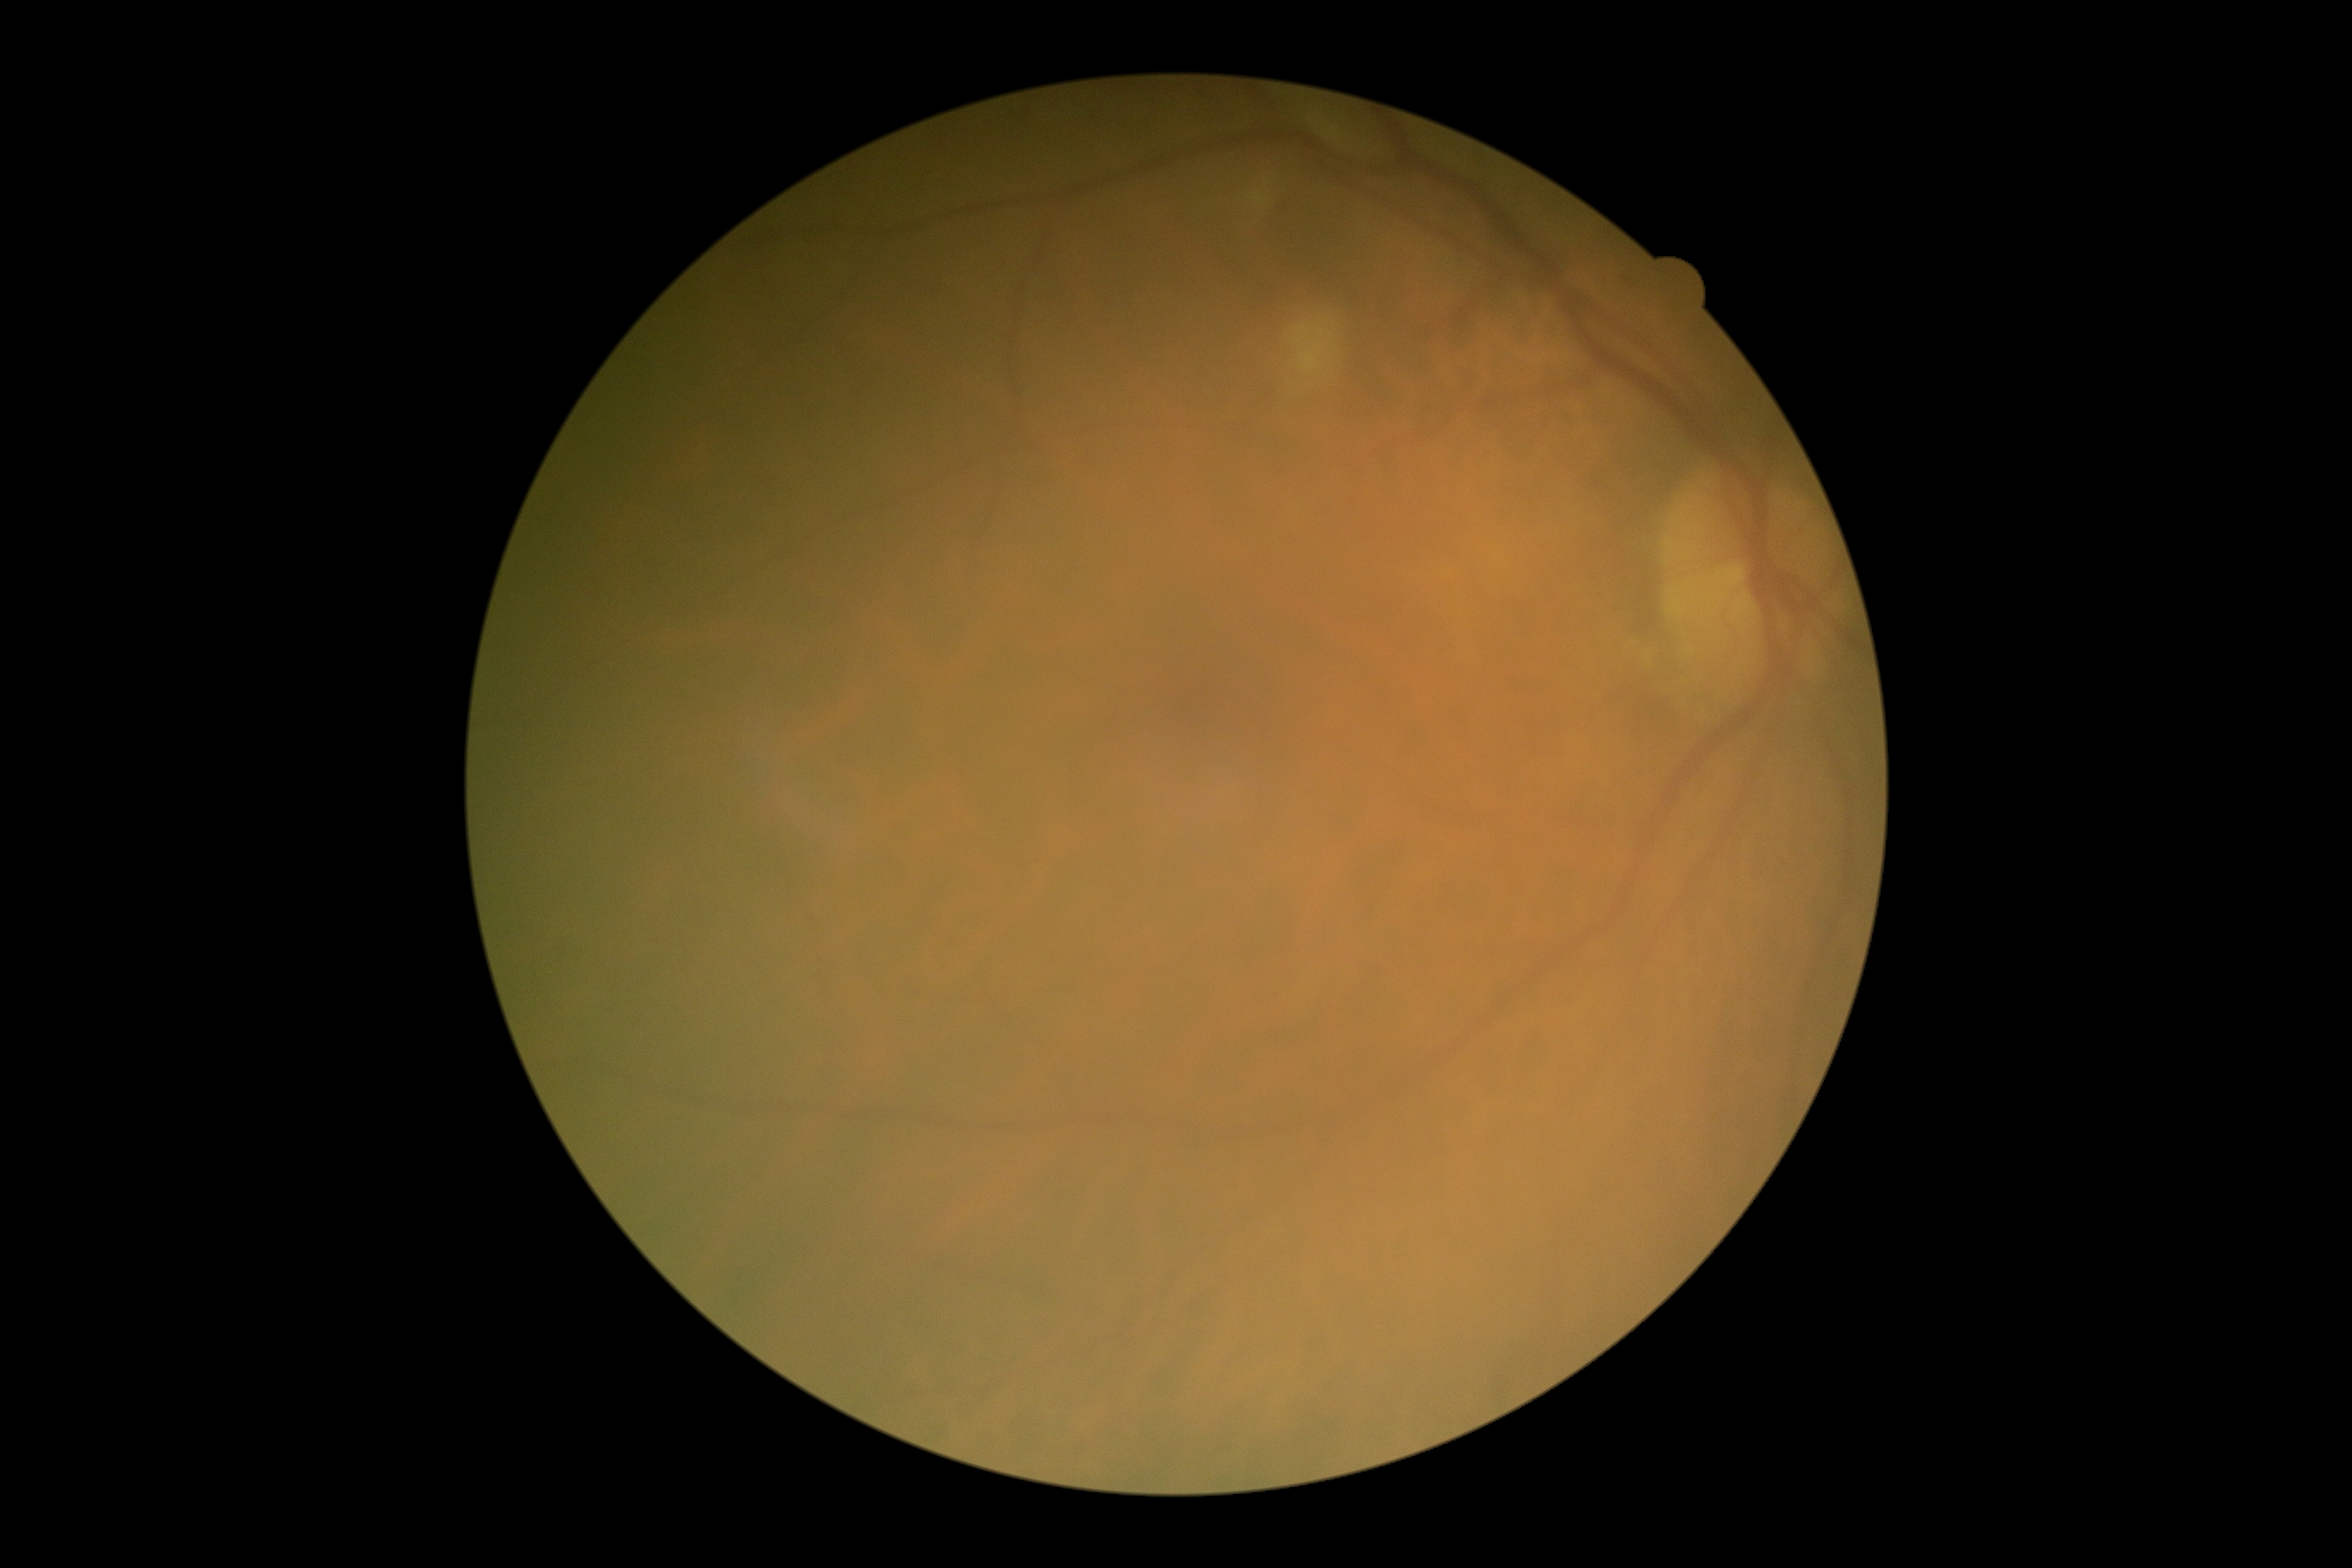 Diabetic retinopathy severity is 2 — more than just microaneurysms but less than severe NPDR.